Retinal fundus photograph; modified Davis grading; acquired with a NIDEK AFC-230 — 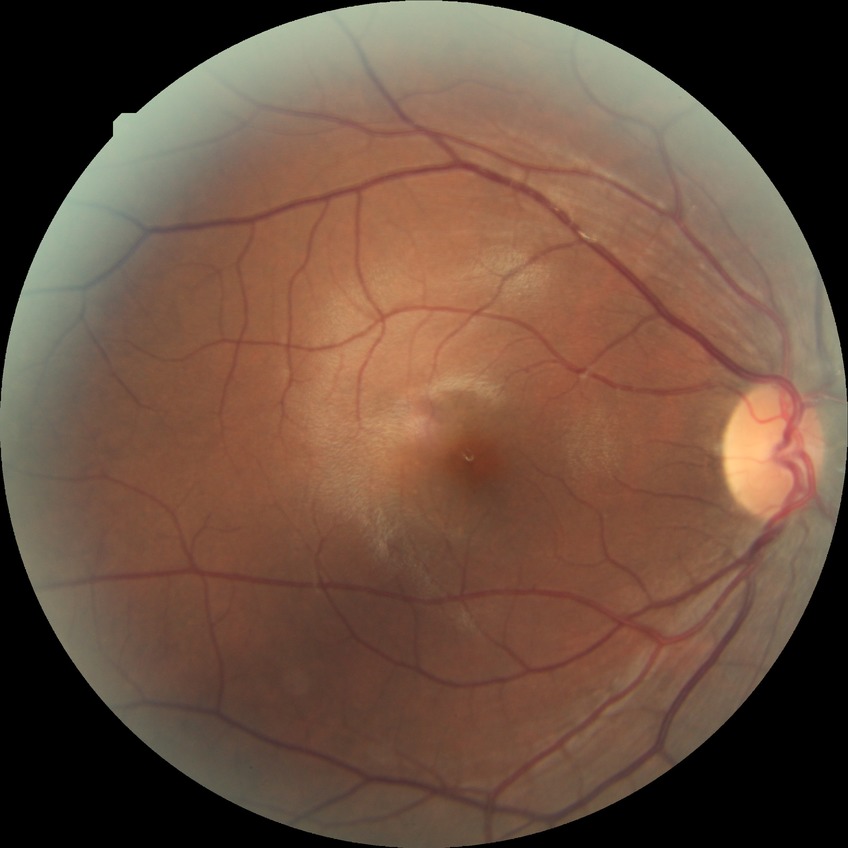

diabetic retinopathy severity=no diabetic retinopathy.